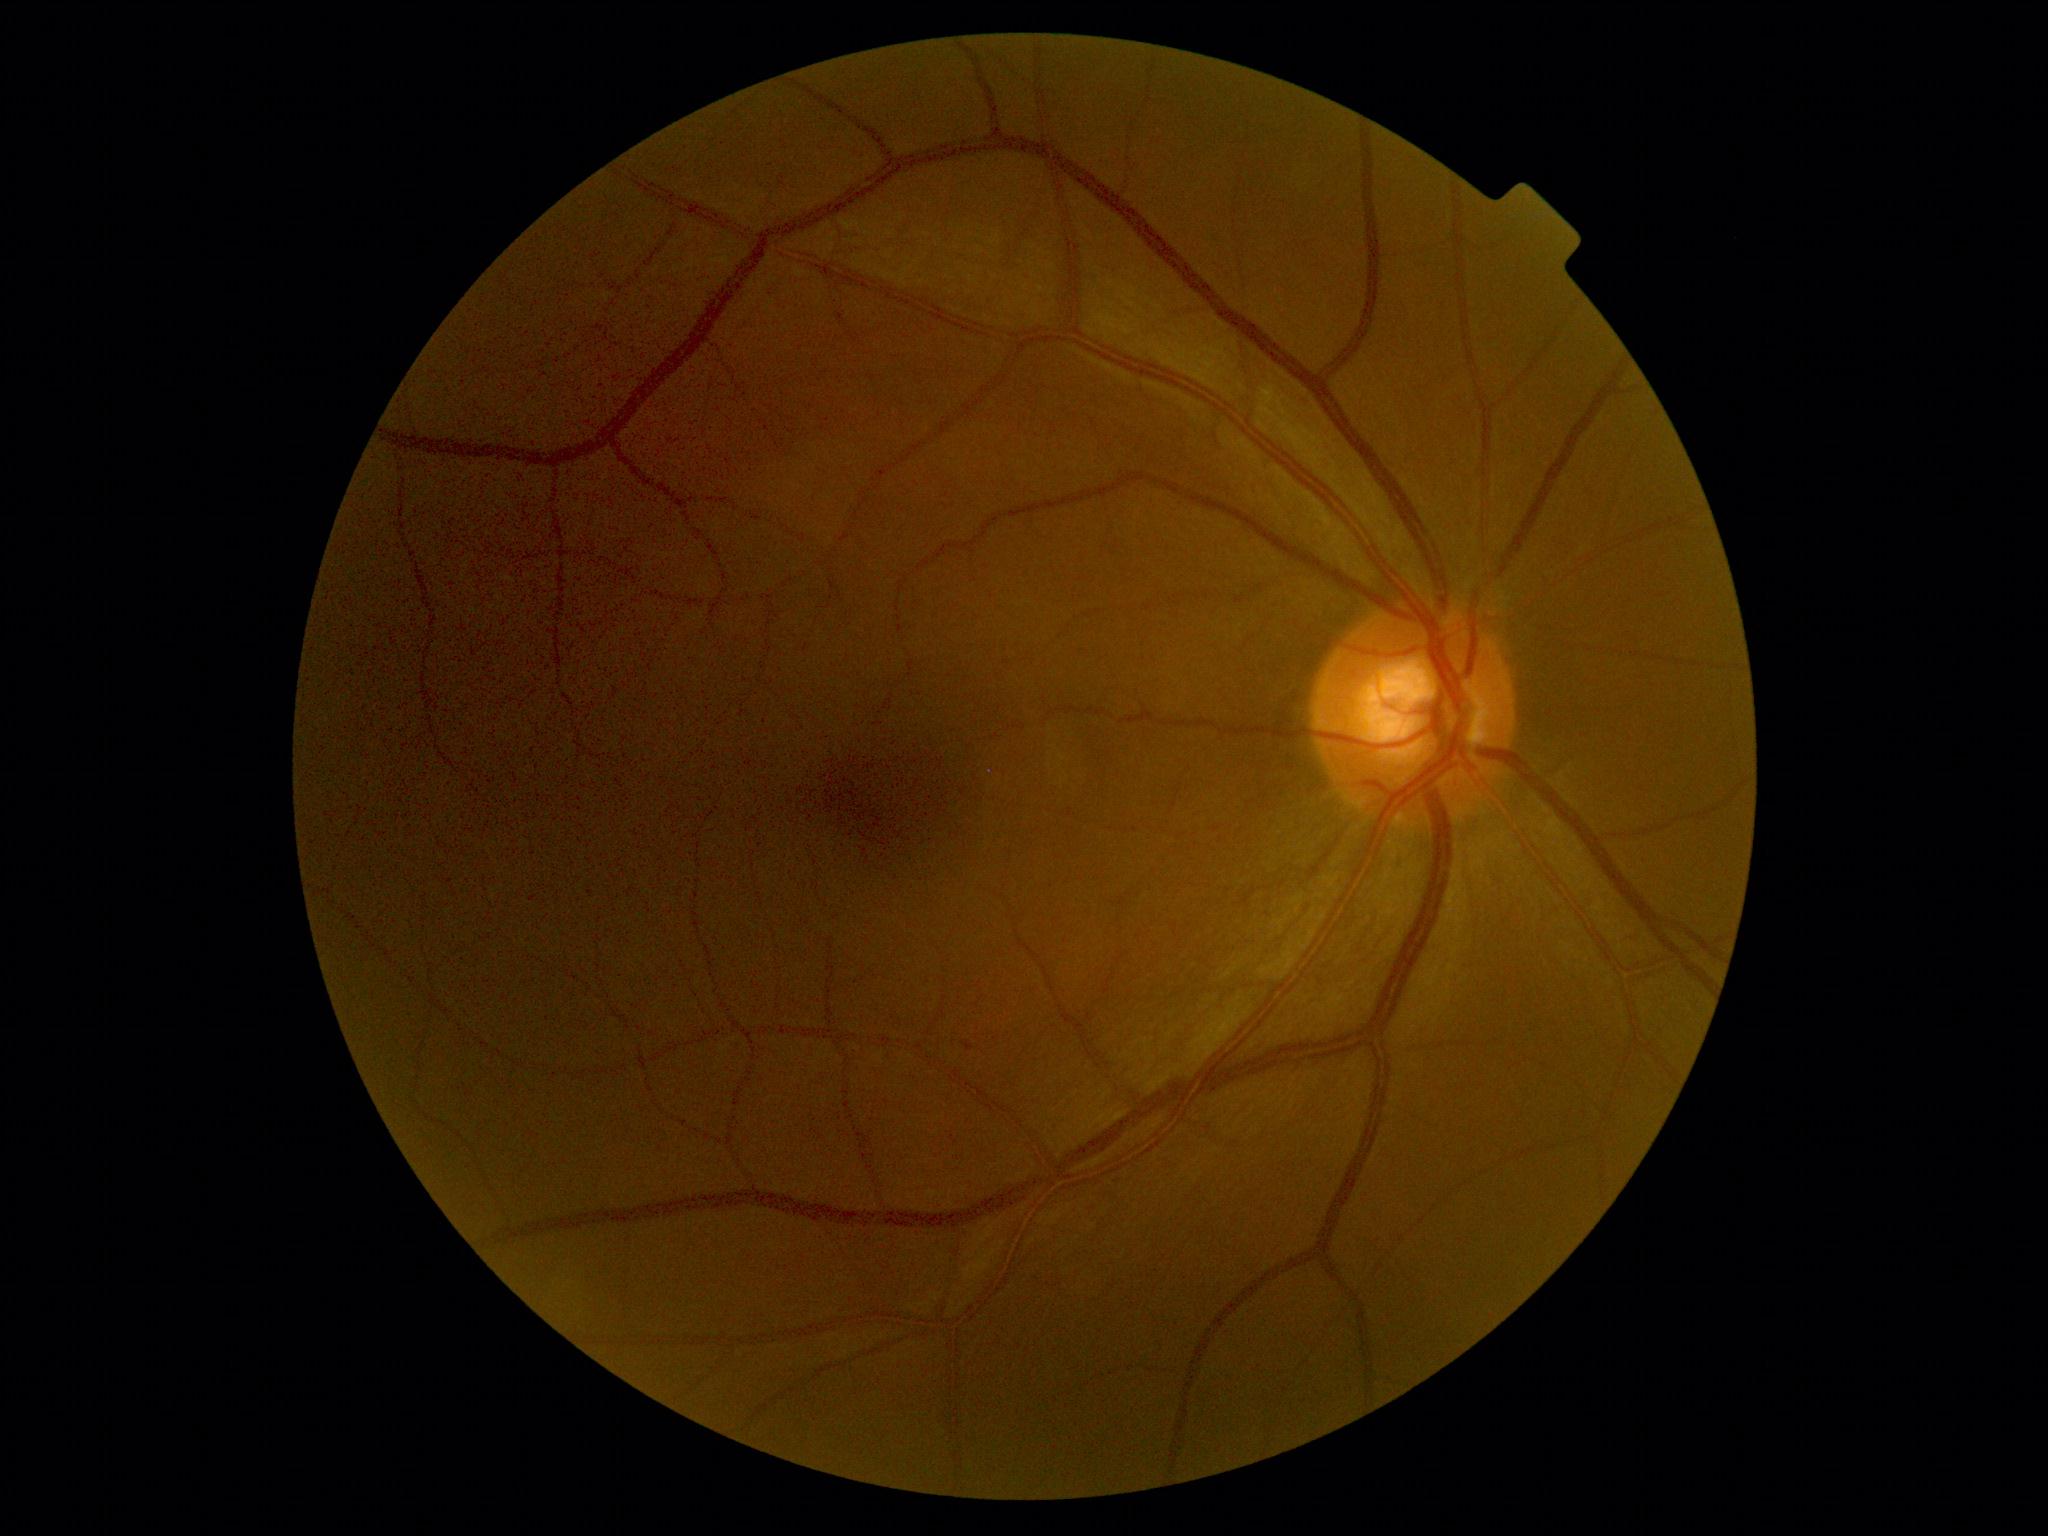 DR is grade 1 (mild NPDR) — presence of microaneurysms only.